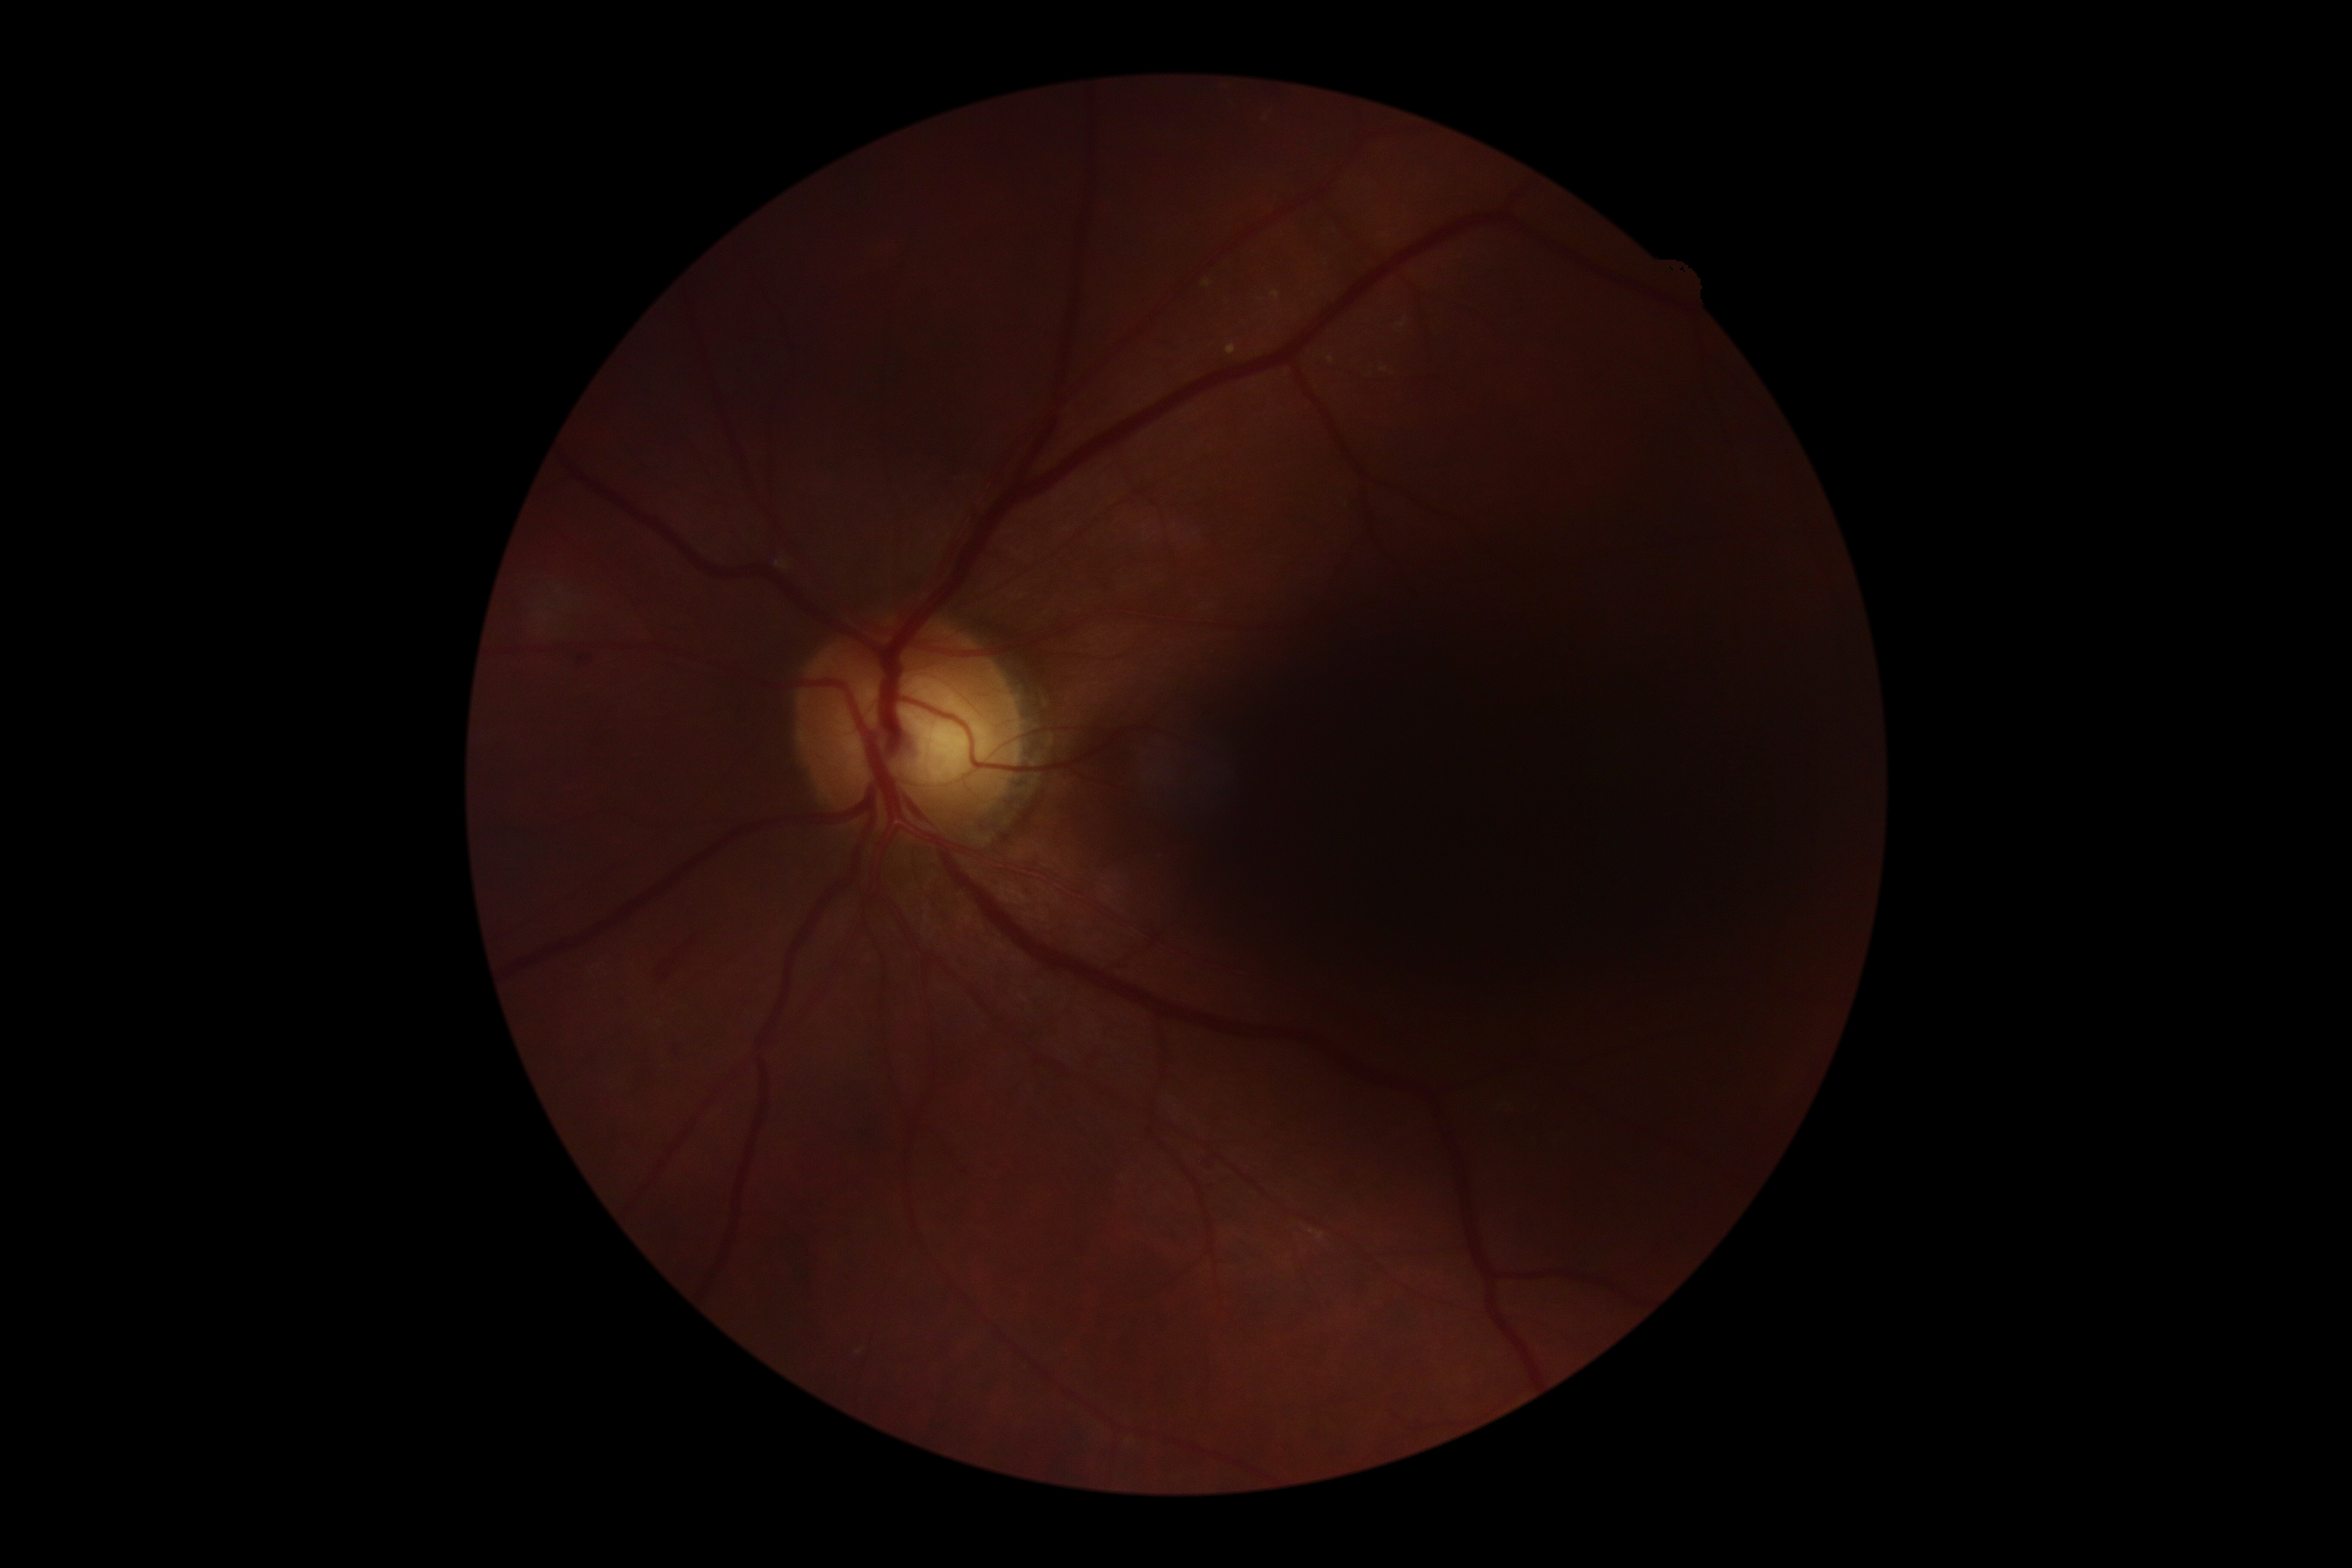
DR class: non-proliferative diabetic retinopathy.
Diabetic retinopathy (DR) is moderate NPDR (grade 2).